Acquired on the Natus RetCam Envision · infant wide-field fundus photograph:
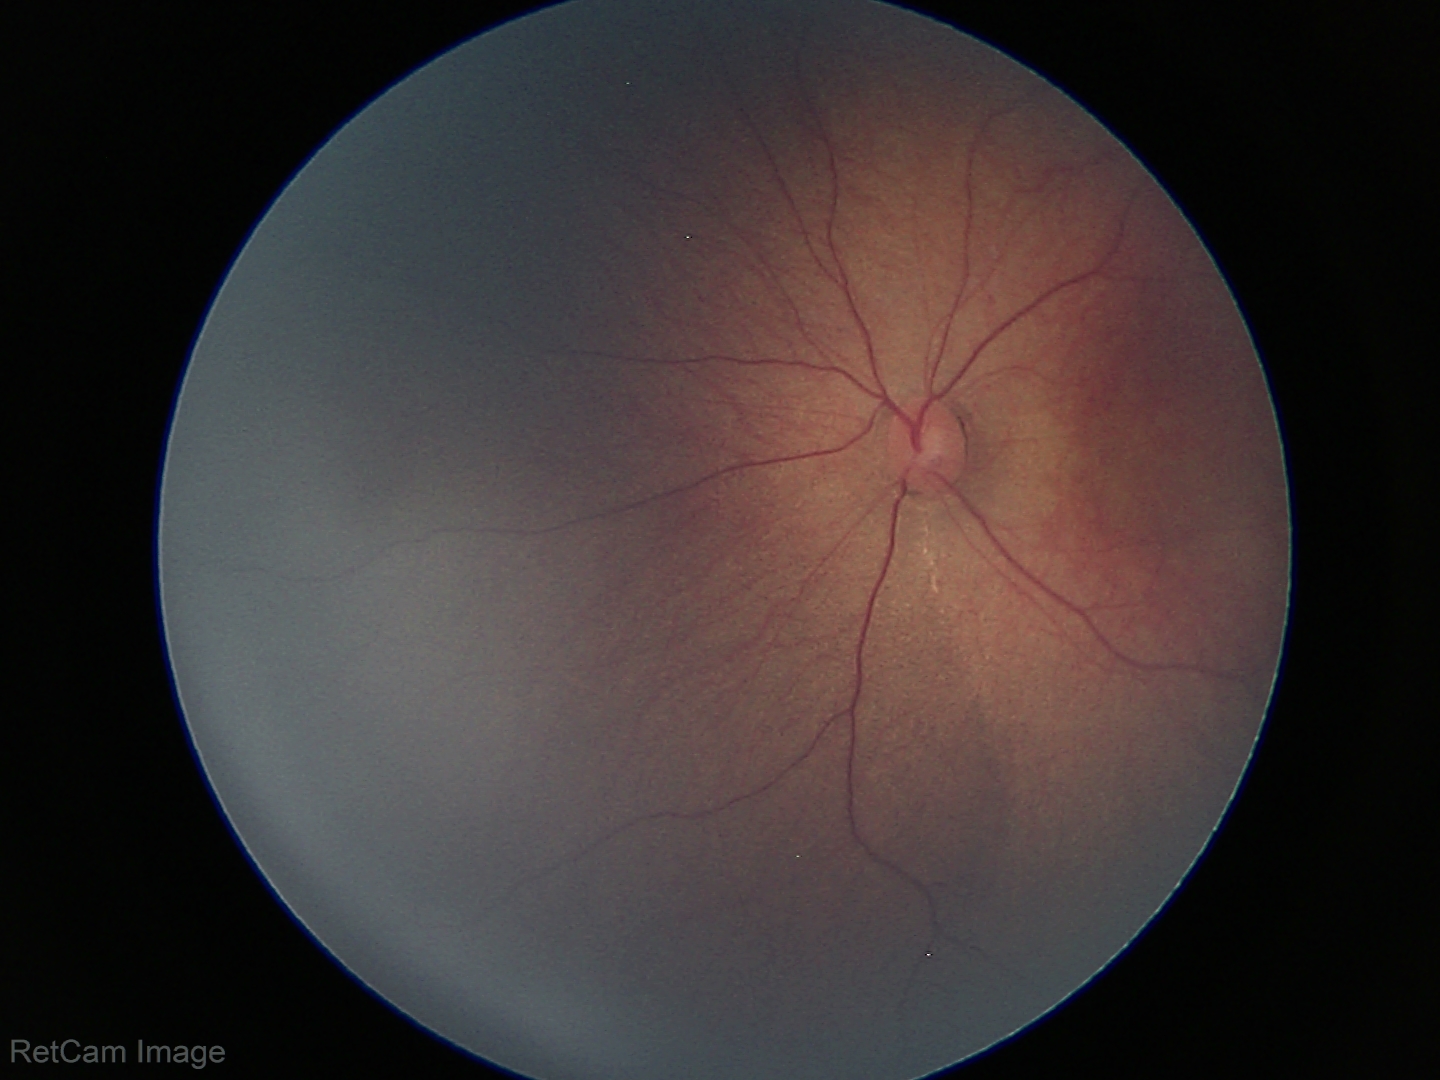 Physiological retinal appearance for postconceptual age.